Non-mydriatic:
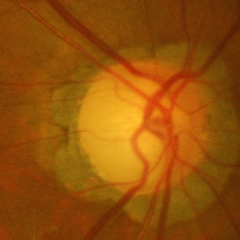

Findings consistent with glaucoma.
Advanced glaucomatous optic neuropathy.